848 x 848 pixels · CFP · NIDEK AFC-230 · nonmydriatic fundus photograph — 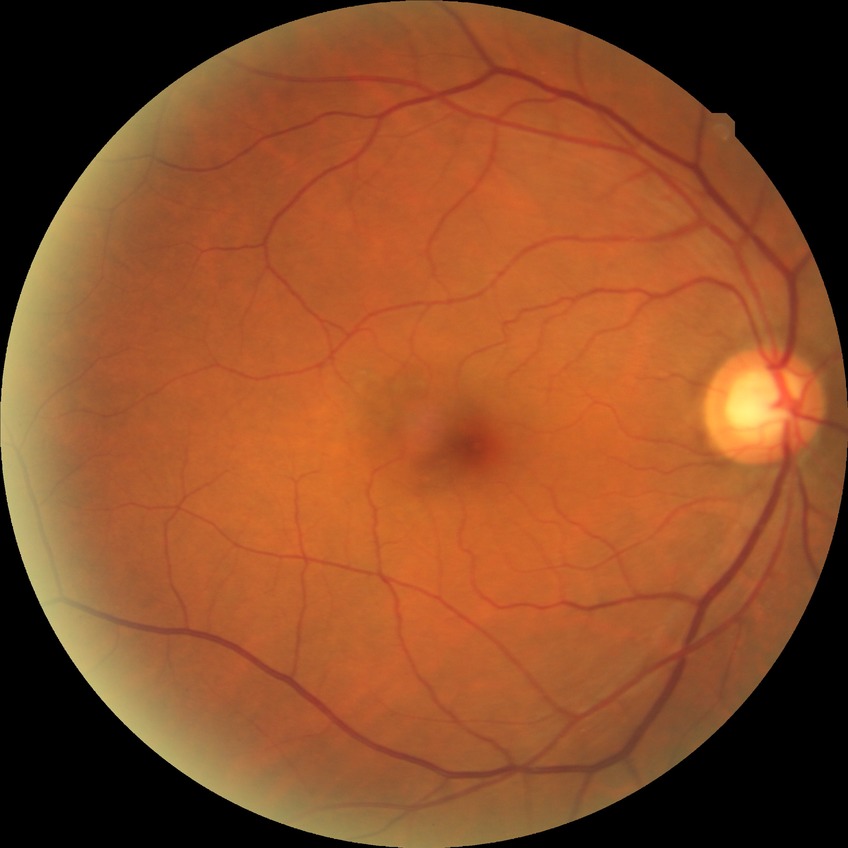

Modified Davis classification is no diabetic retinopathy.